NIDEK AFC-230 fundus camera.
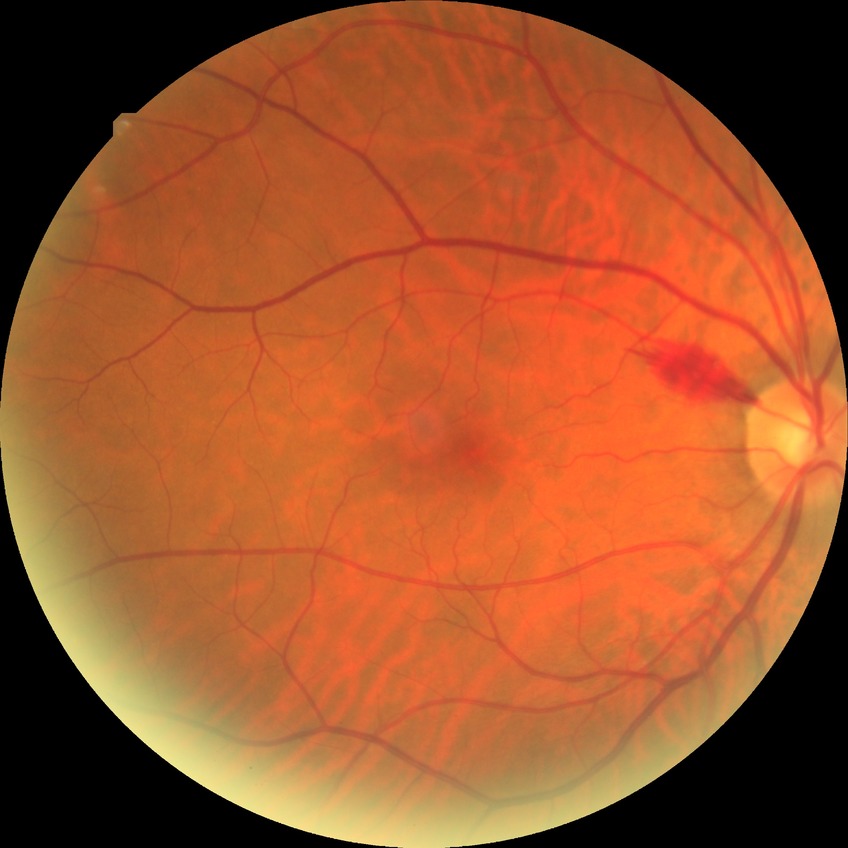 Modified Davis grading: no diabetic retinopathy.